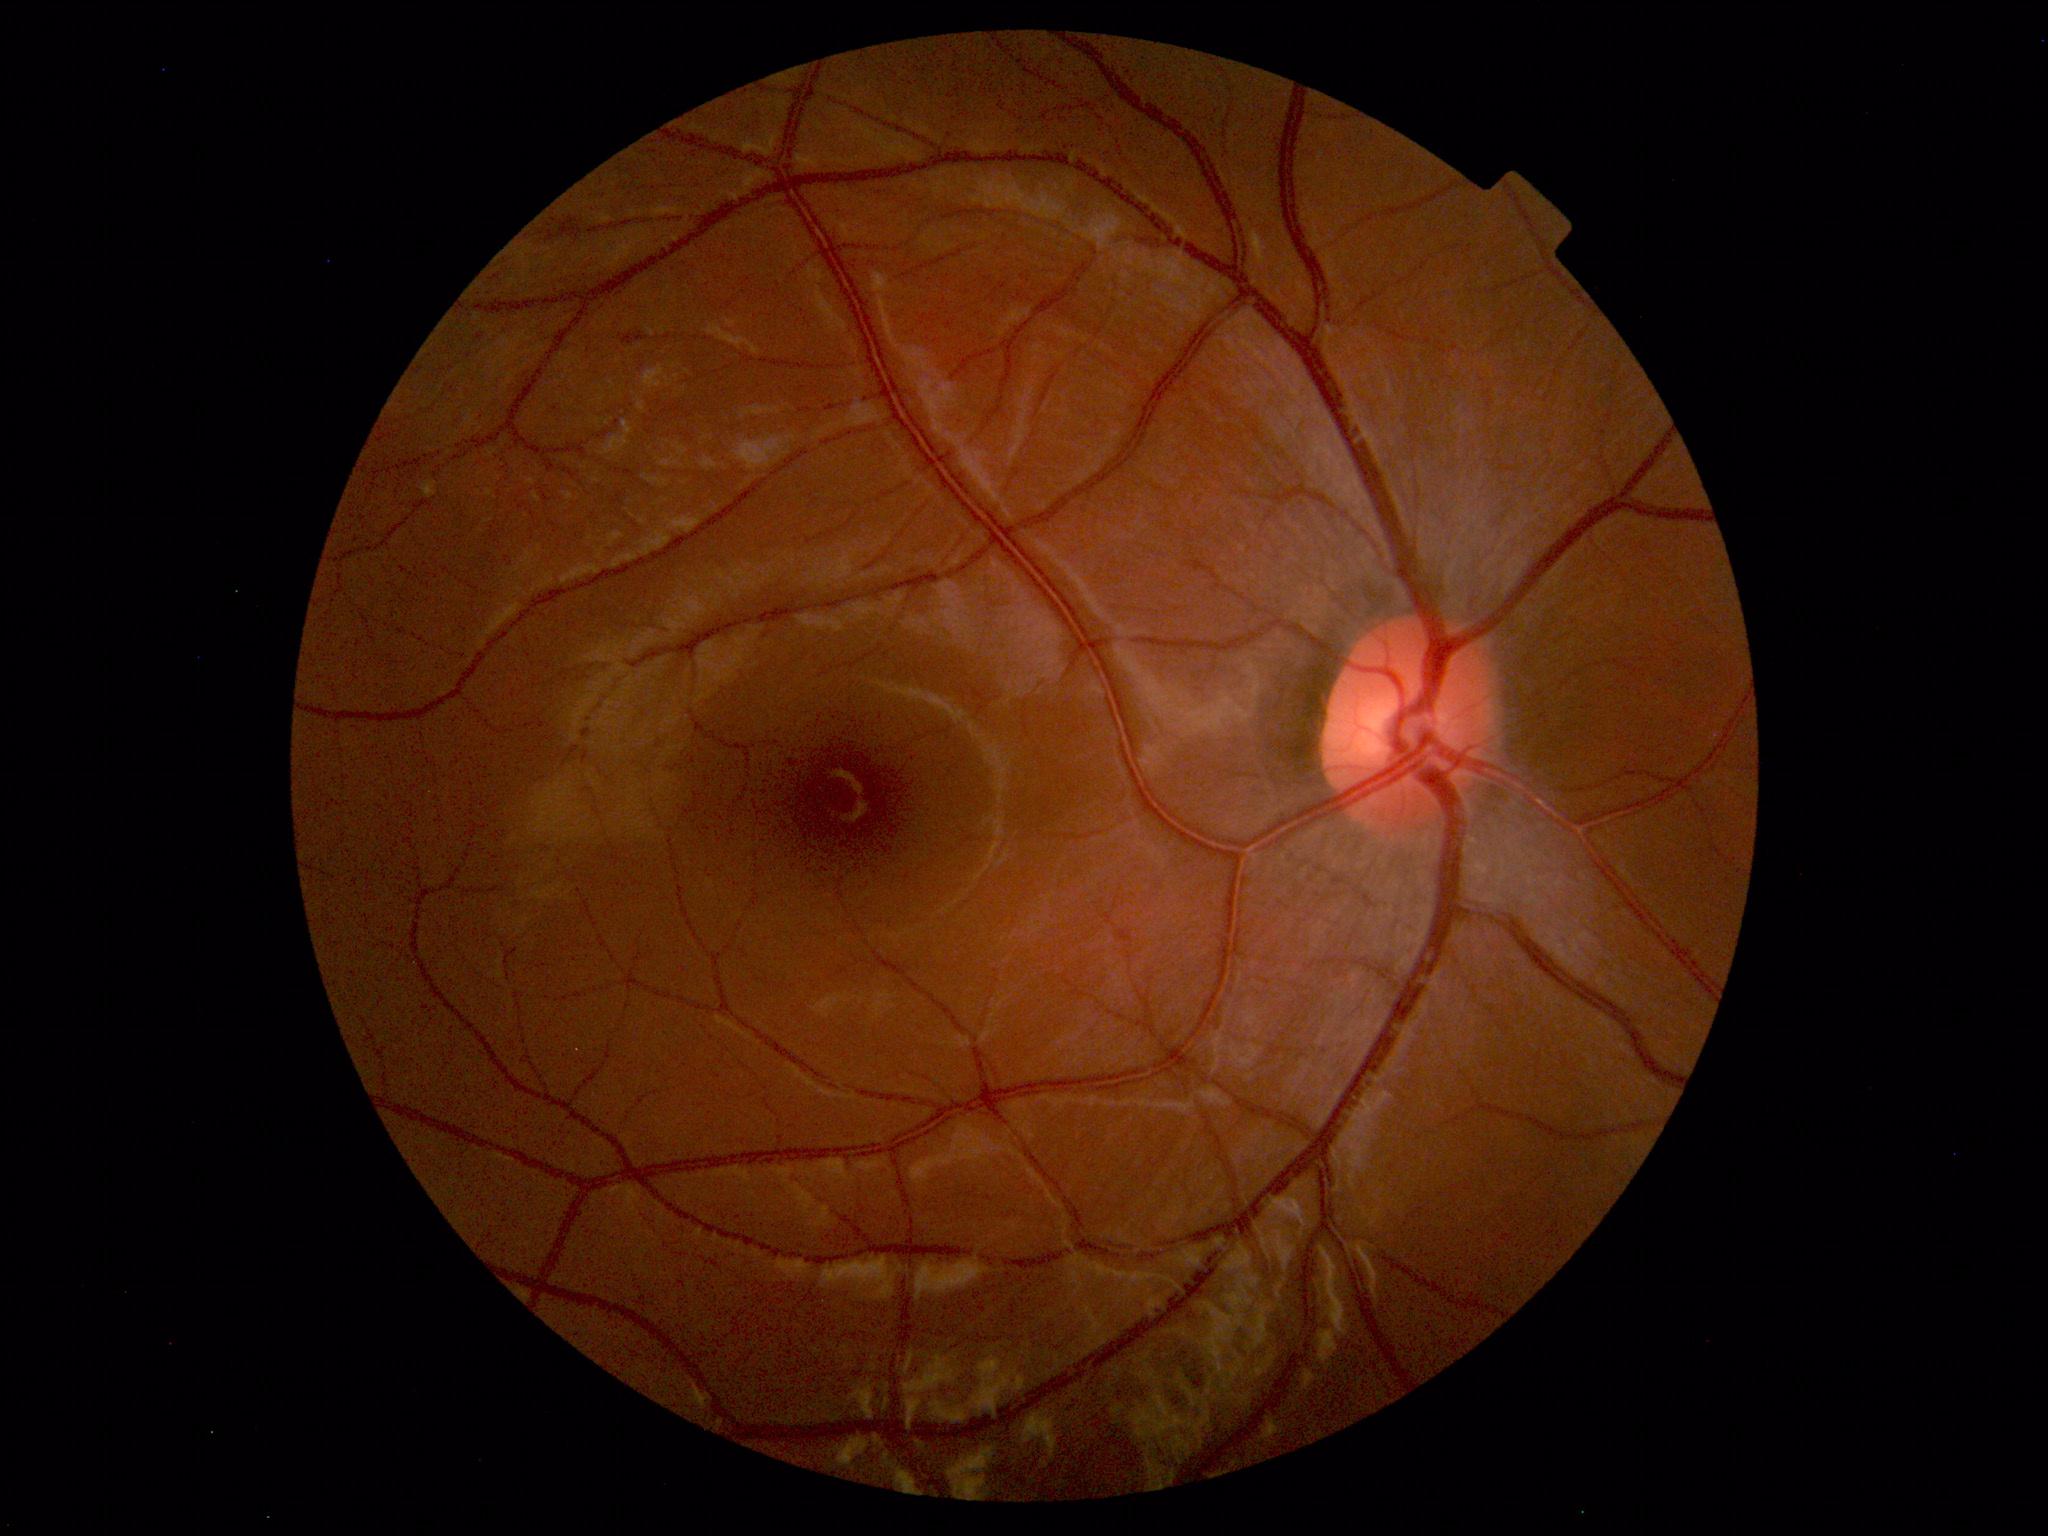
Diagnosis: normal.